FOV: 45 degrees, DR severity per modified Davis staging, NIDEK AFC-230 fundus camera:
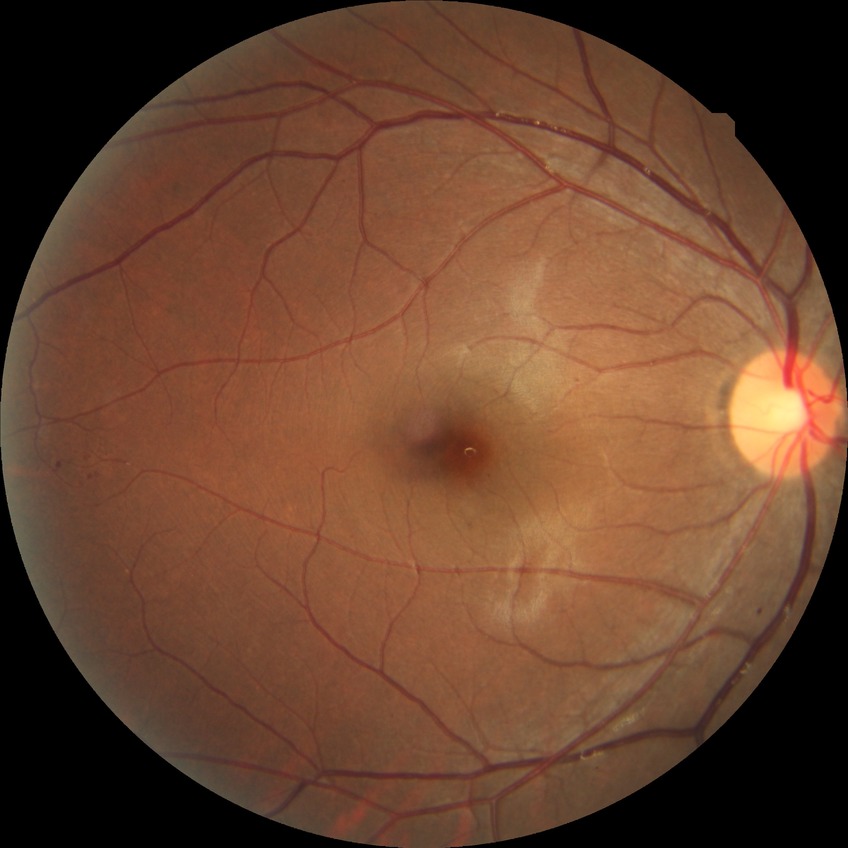
diabetic retinopathy (DR): SDR (simple diabetic retinopathy).